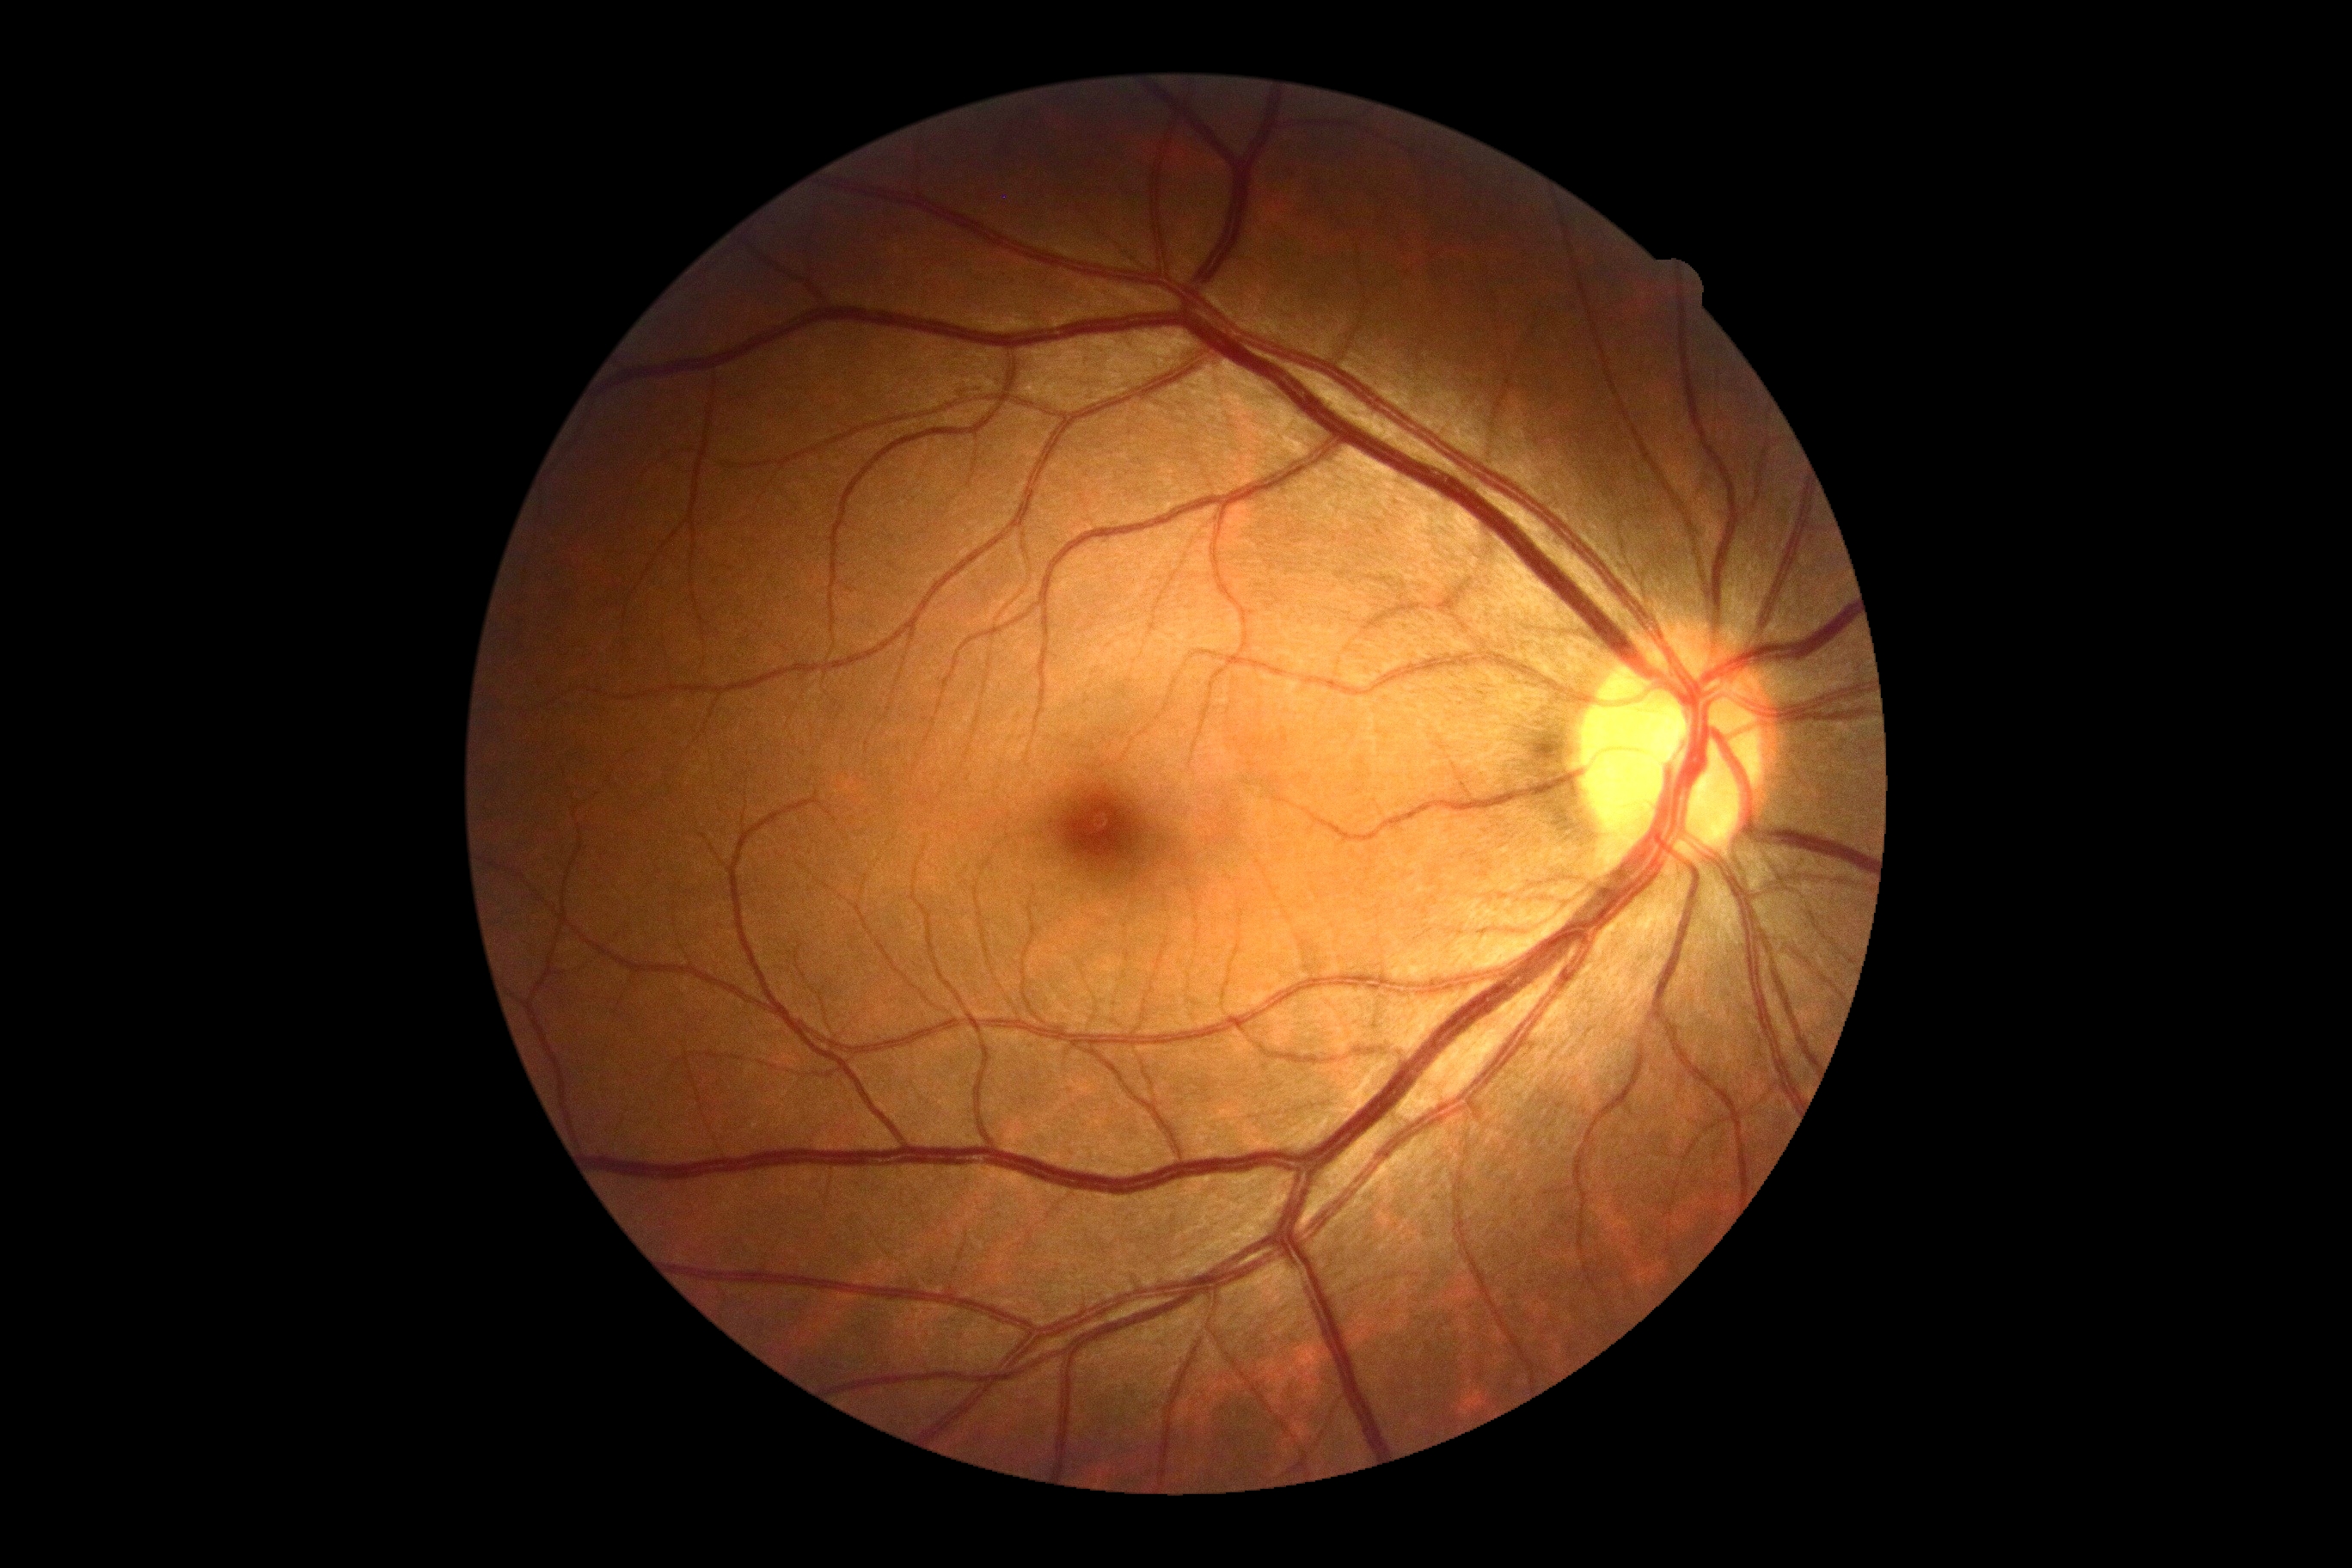

diabetic retinopathy (DR) = 0